Davis DR grading, 45-degree field of view
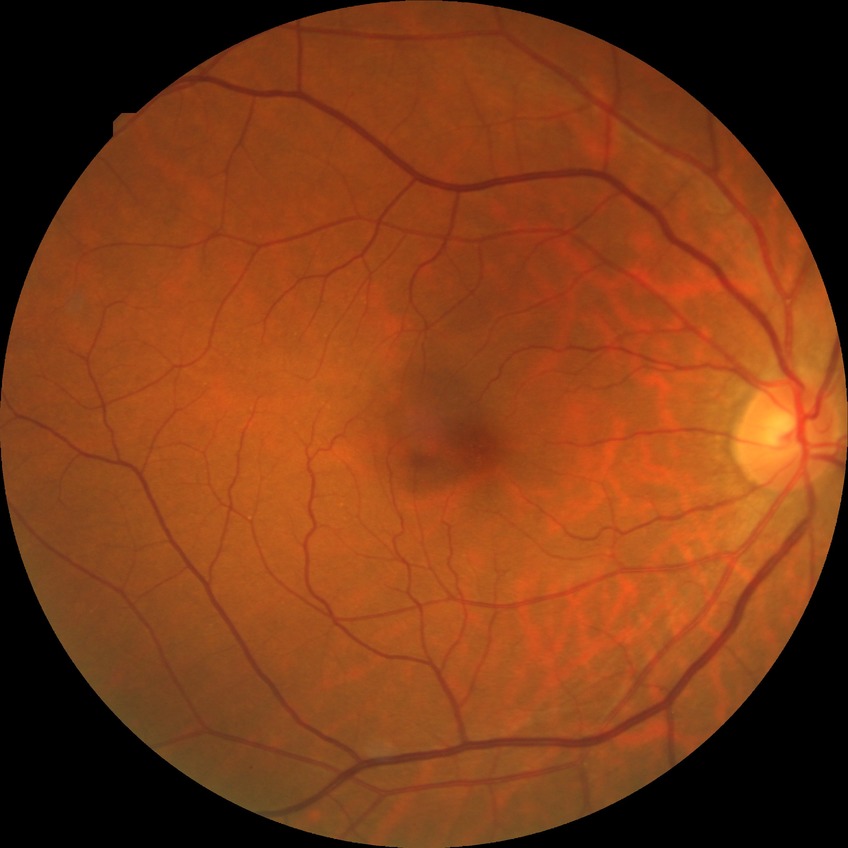
diabetic retinopathy (DR) = no diabetic retinopathy (NDR)